Without pupil dilation.
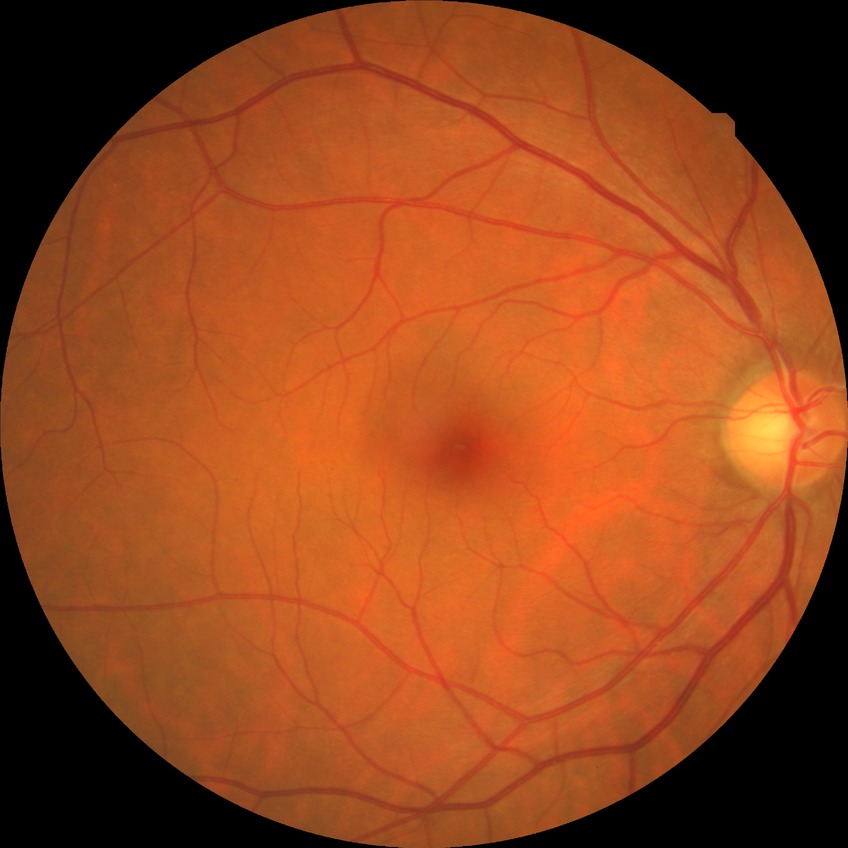 DR grade = NDR.